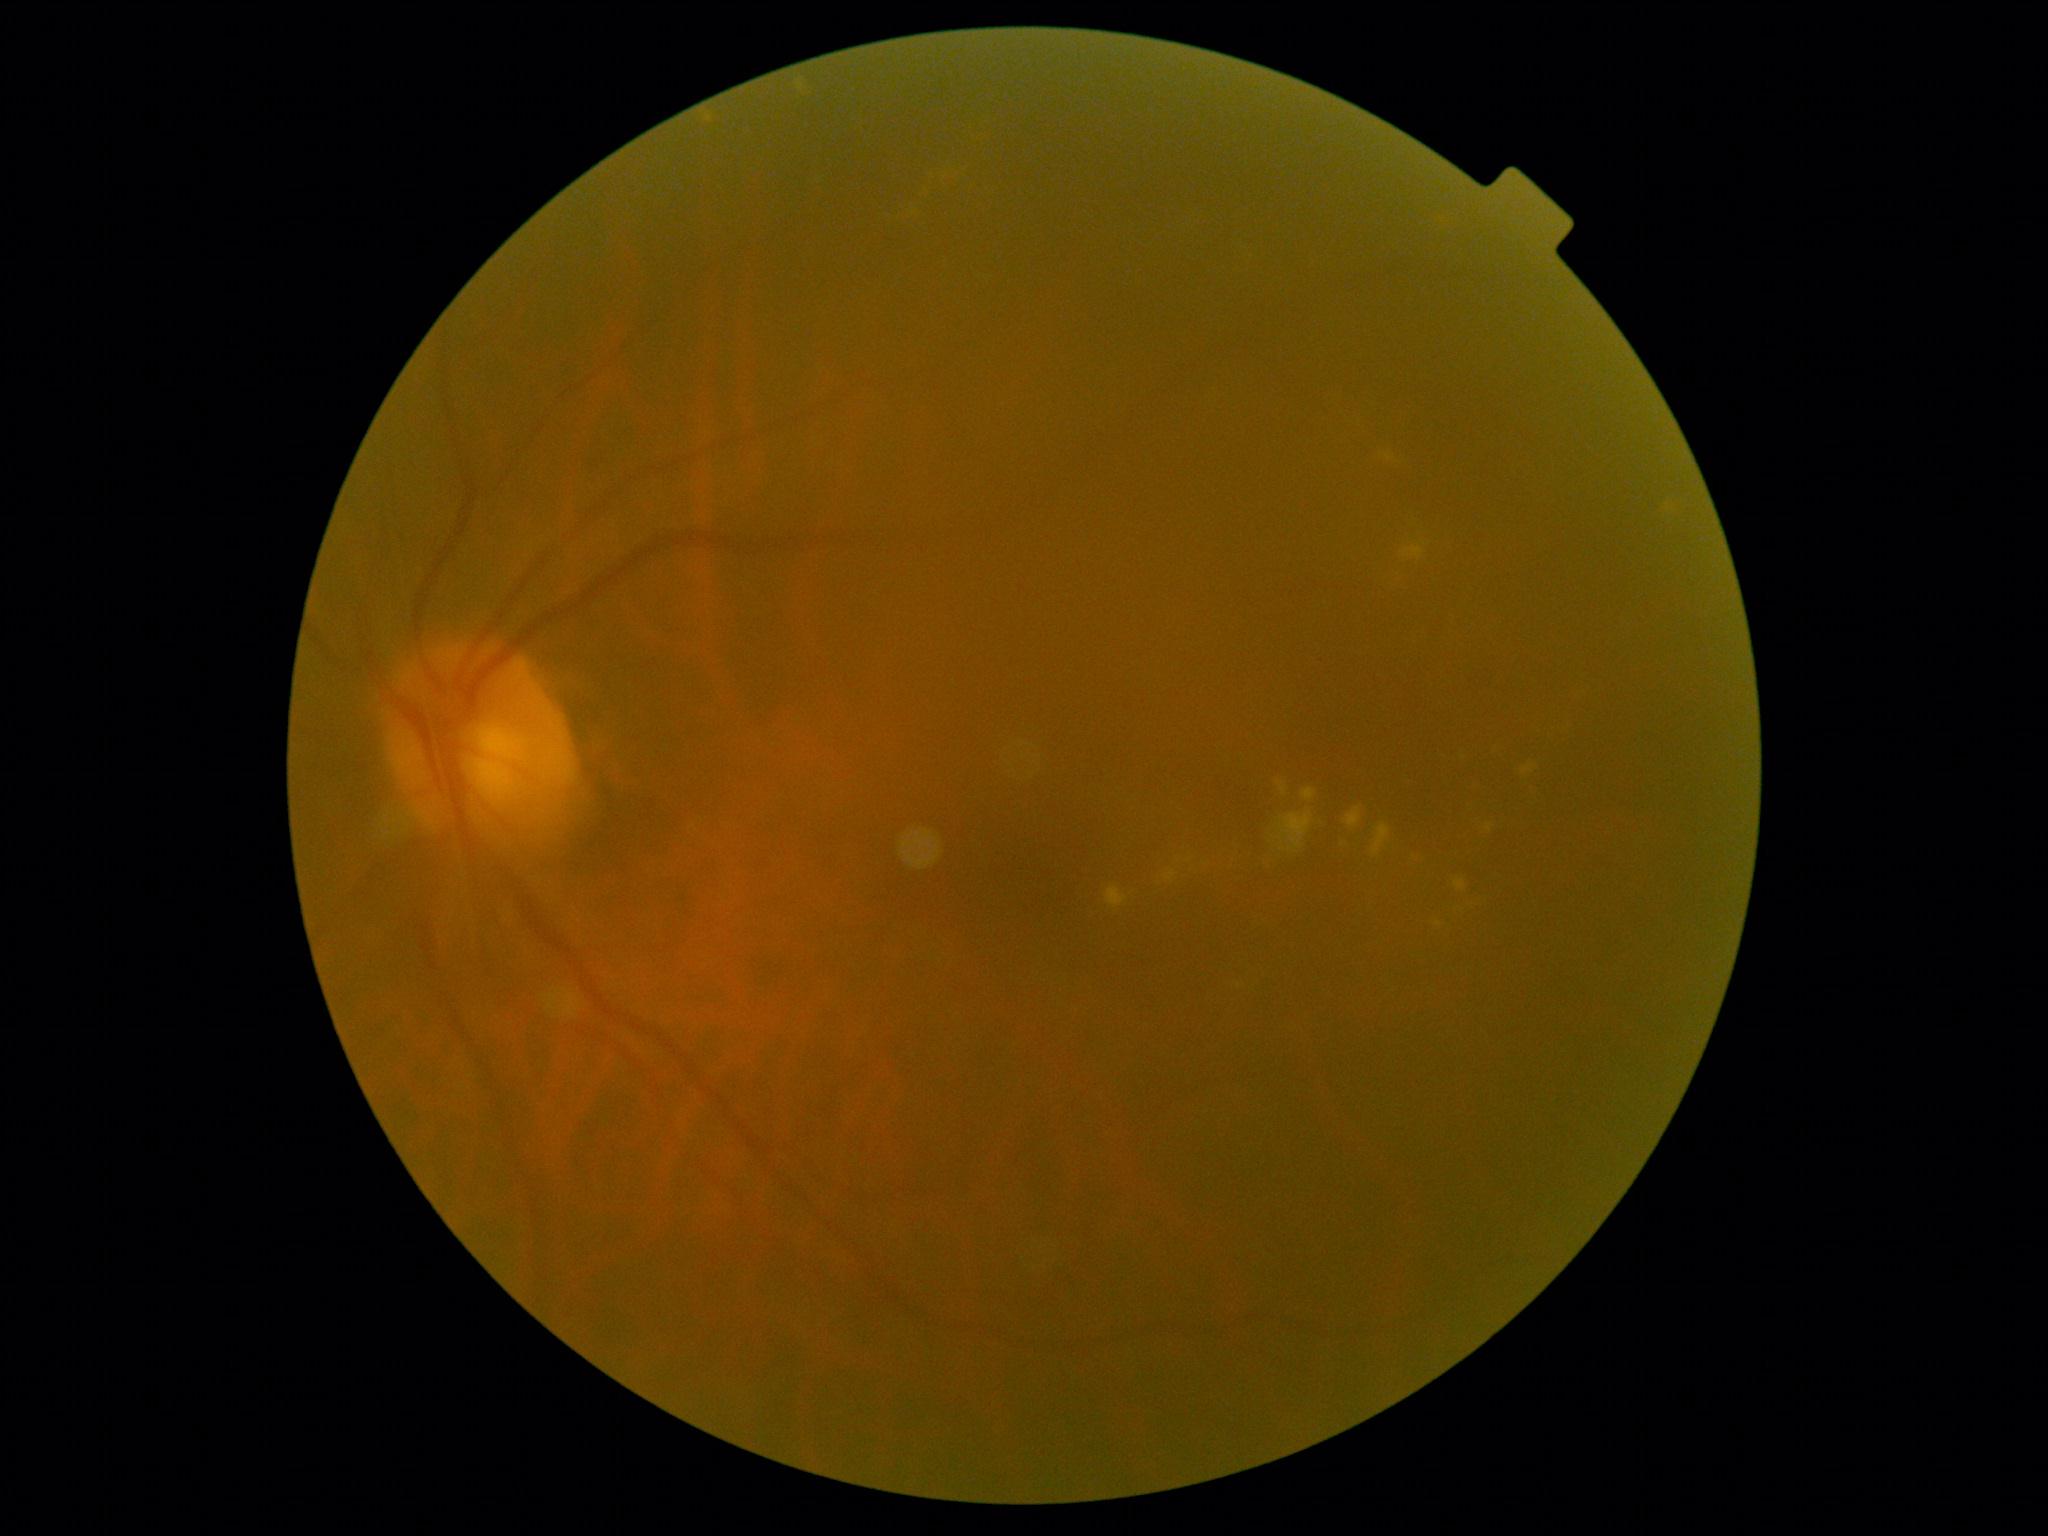 DR stage=grade 2 (moderate NPDR).